45 degree fundus photograph; NIDEK AFC-230 fundus camera; nonmydriatic fundus photograph — 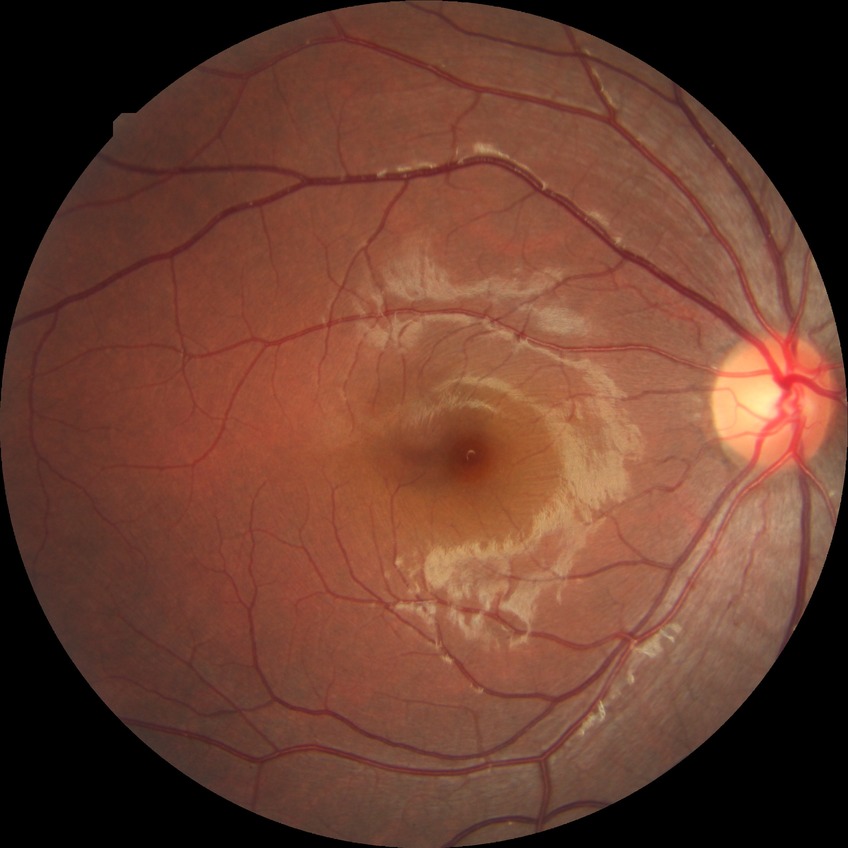

Davis grading is no diabetic retinopathy.